45° FOV; without pupil dilation; NIDEK AFC-230.
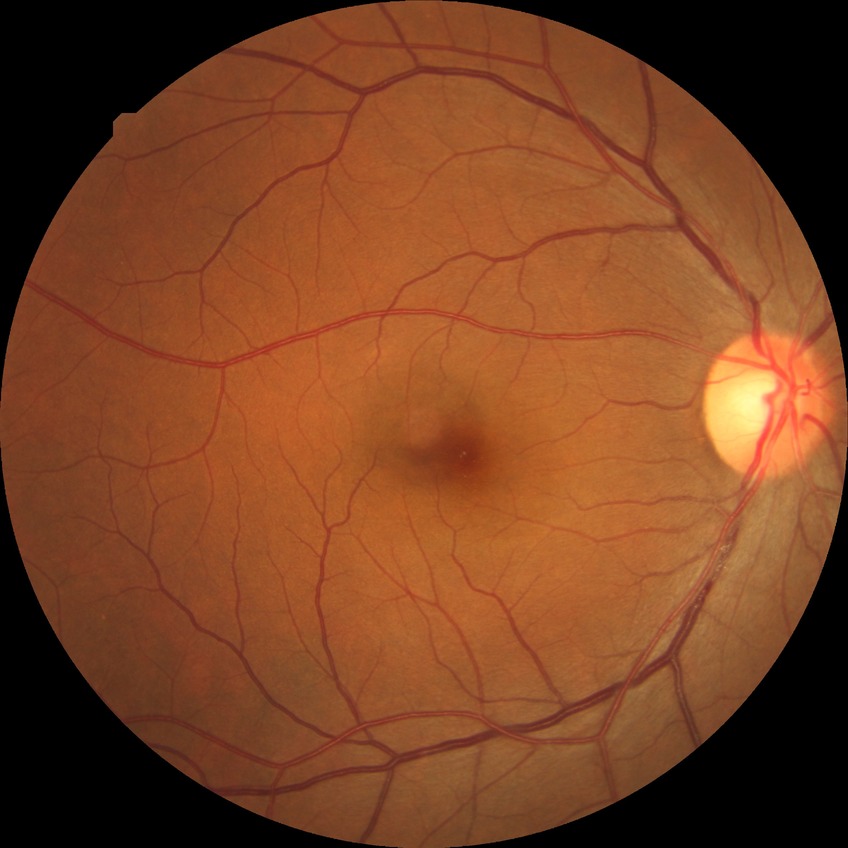 DR: NDR.